2346 by 1568 pixels — 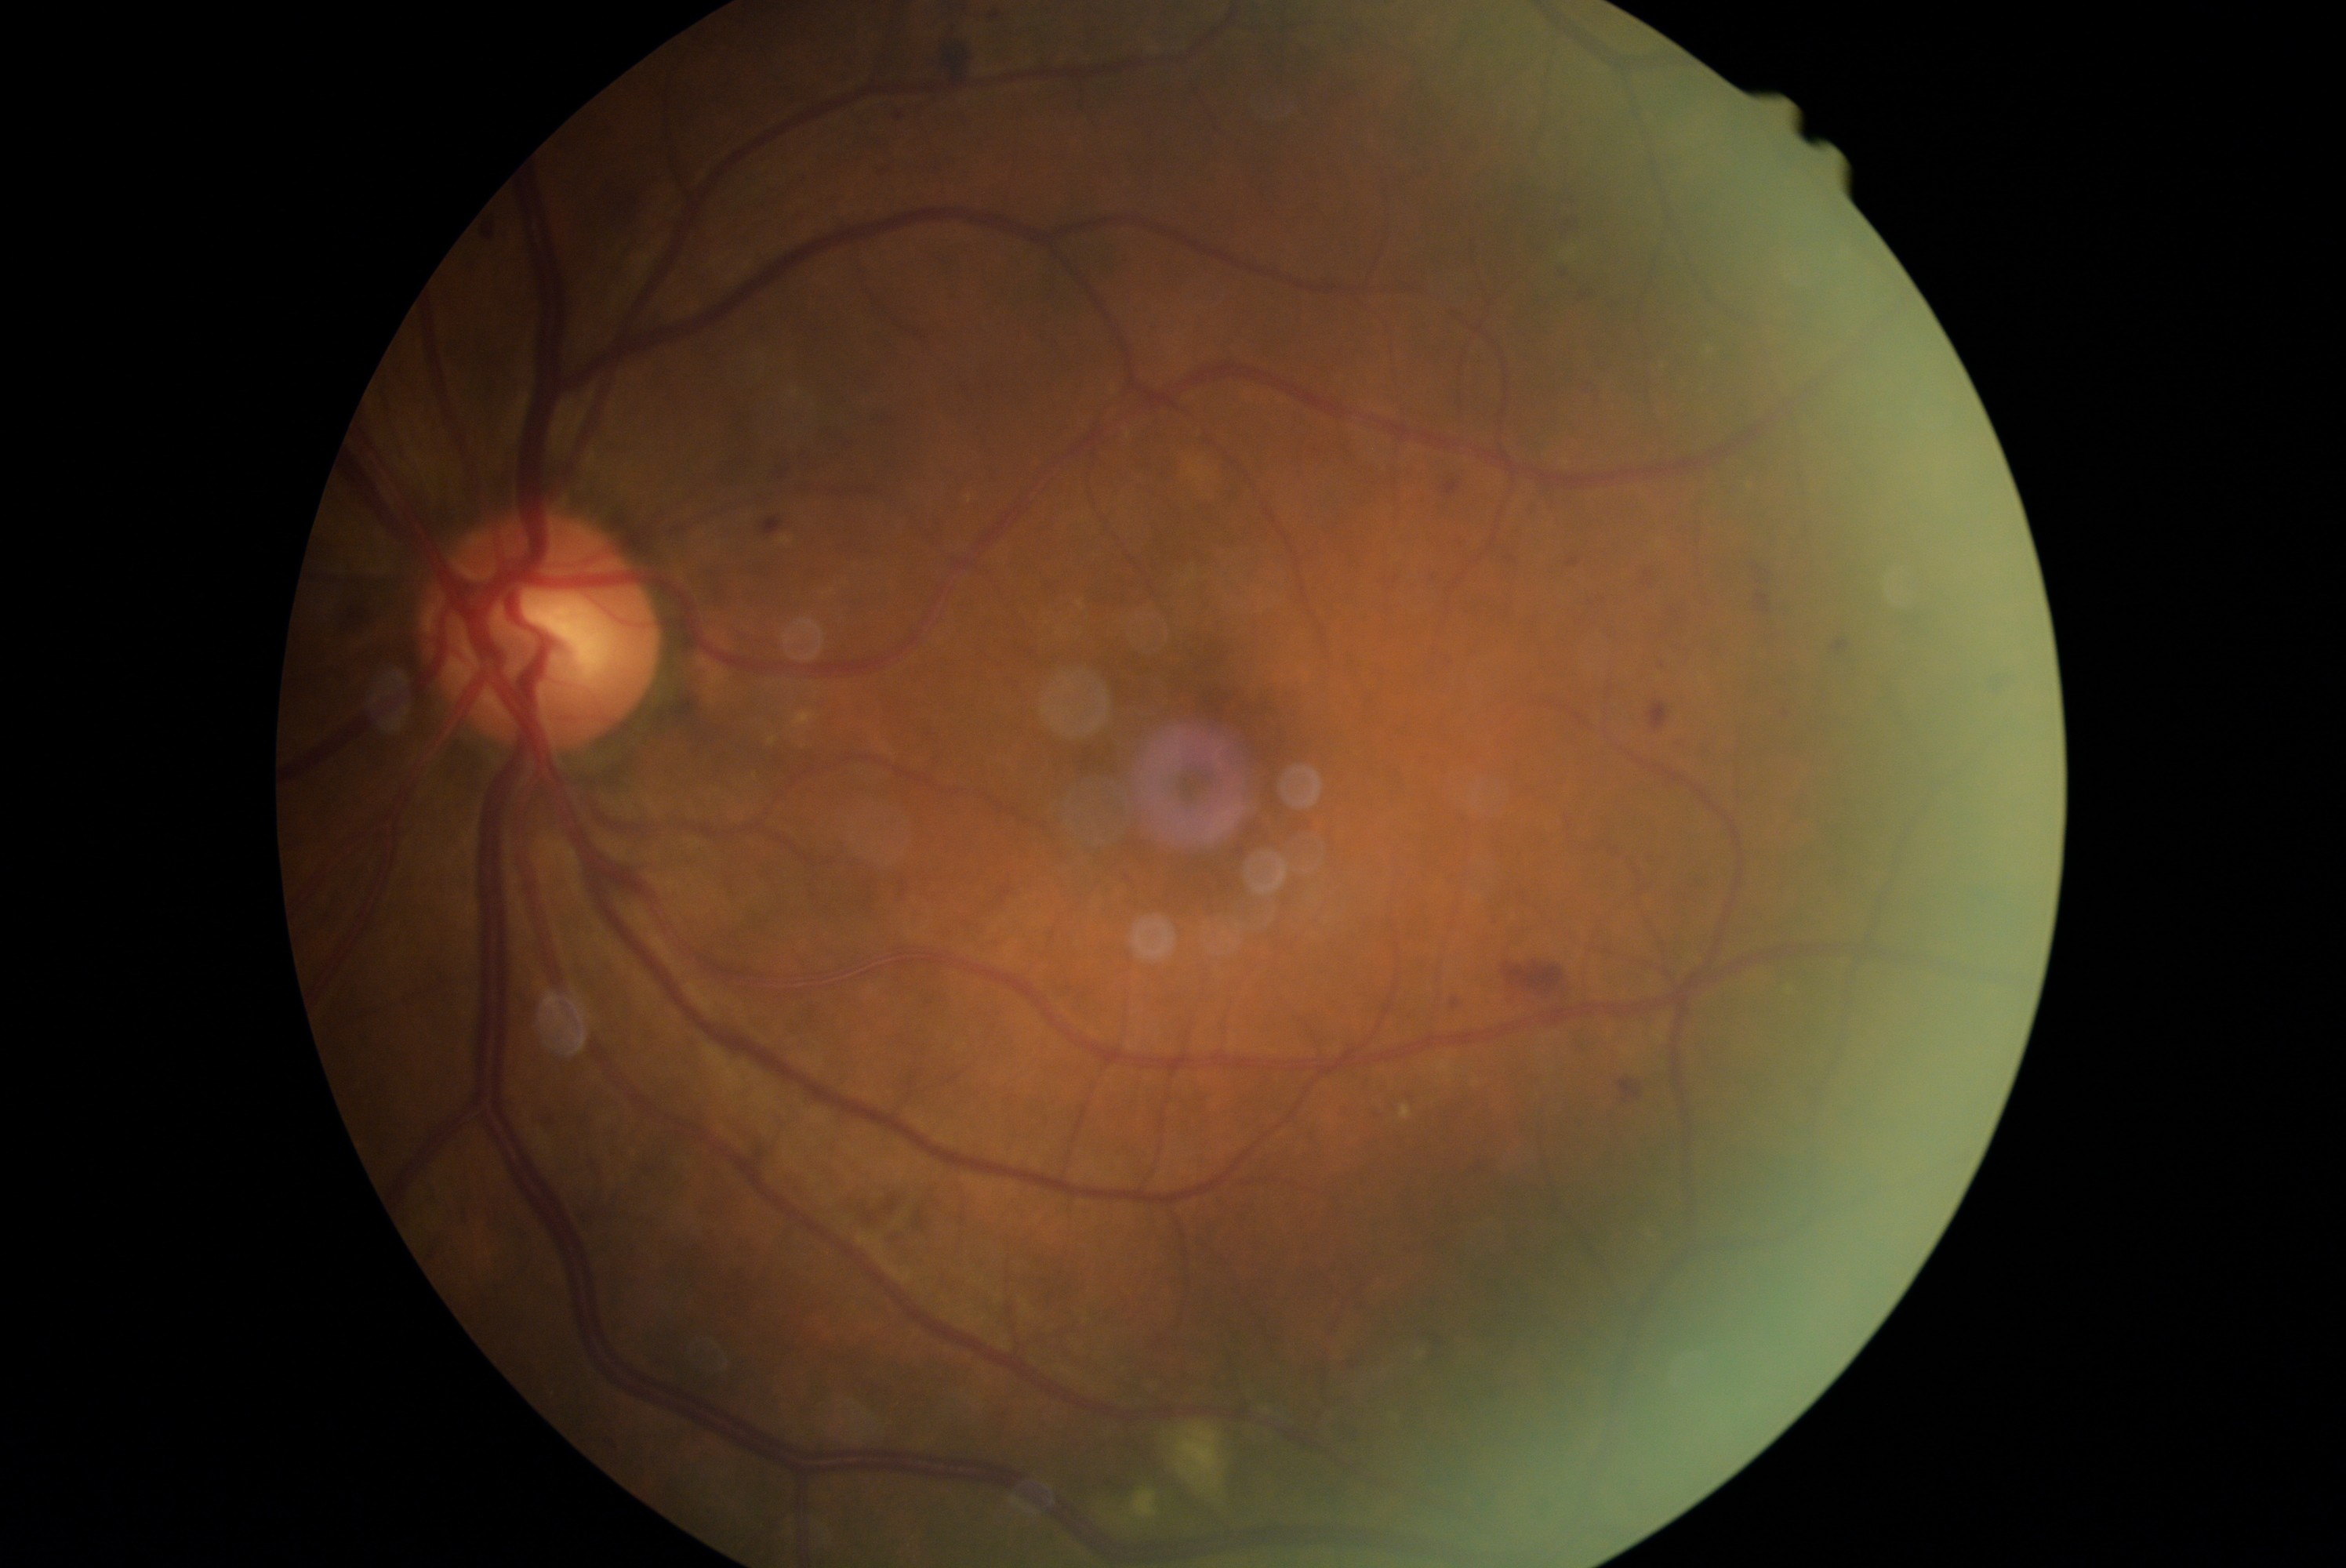
{"dr_grade": "moderate NPDR (grade 2)"}